Diabetic retinopathy graded by the modified Davis classification. 45 degree fundus photograph. Image size 848x848. Color fundus image:
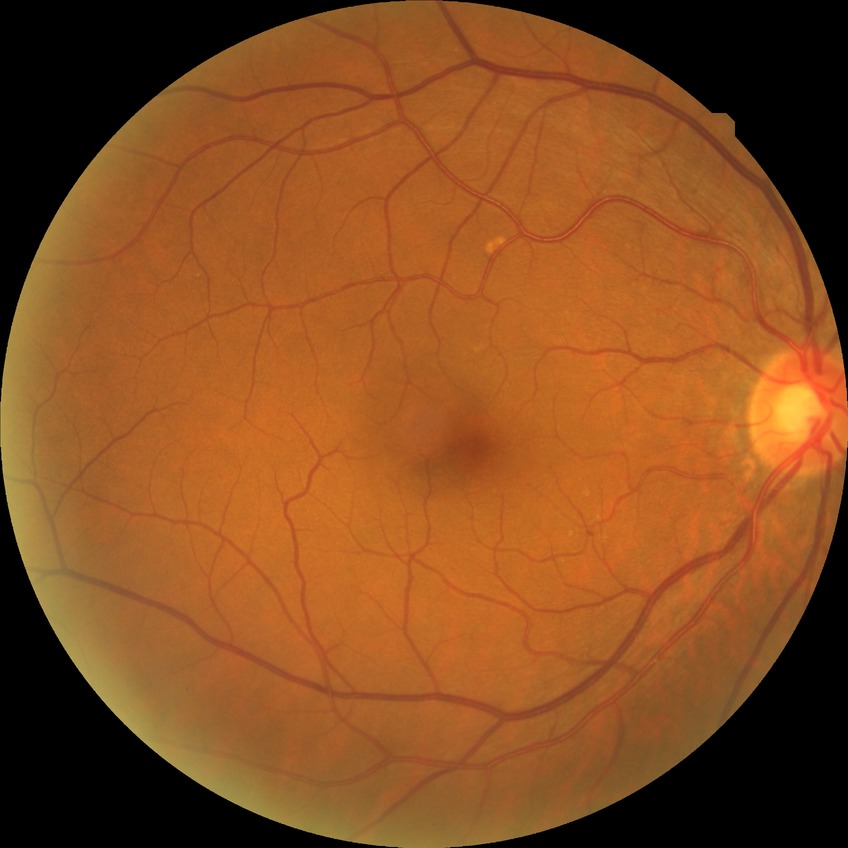

diabetic retinopathy stage: no diabetic retinopathy